45-degree field of view:
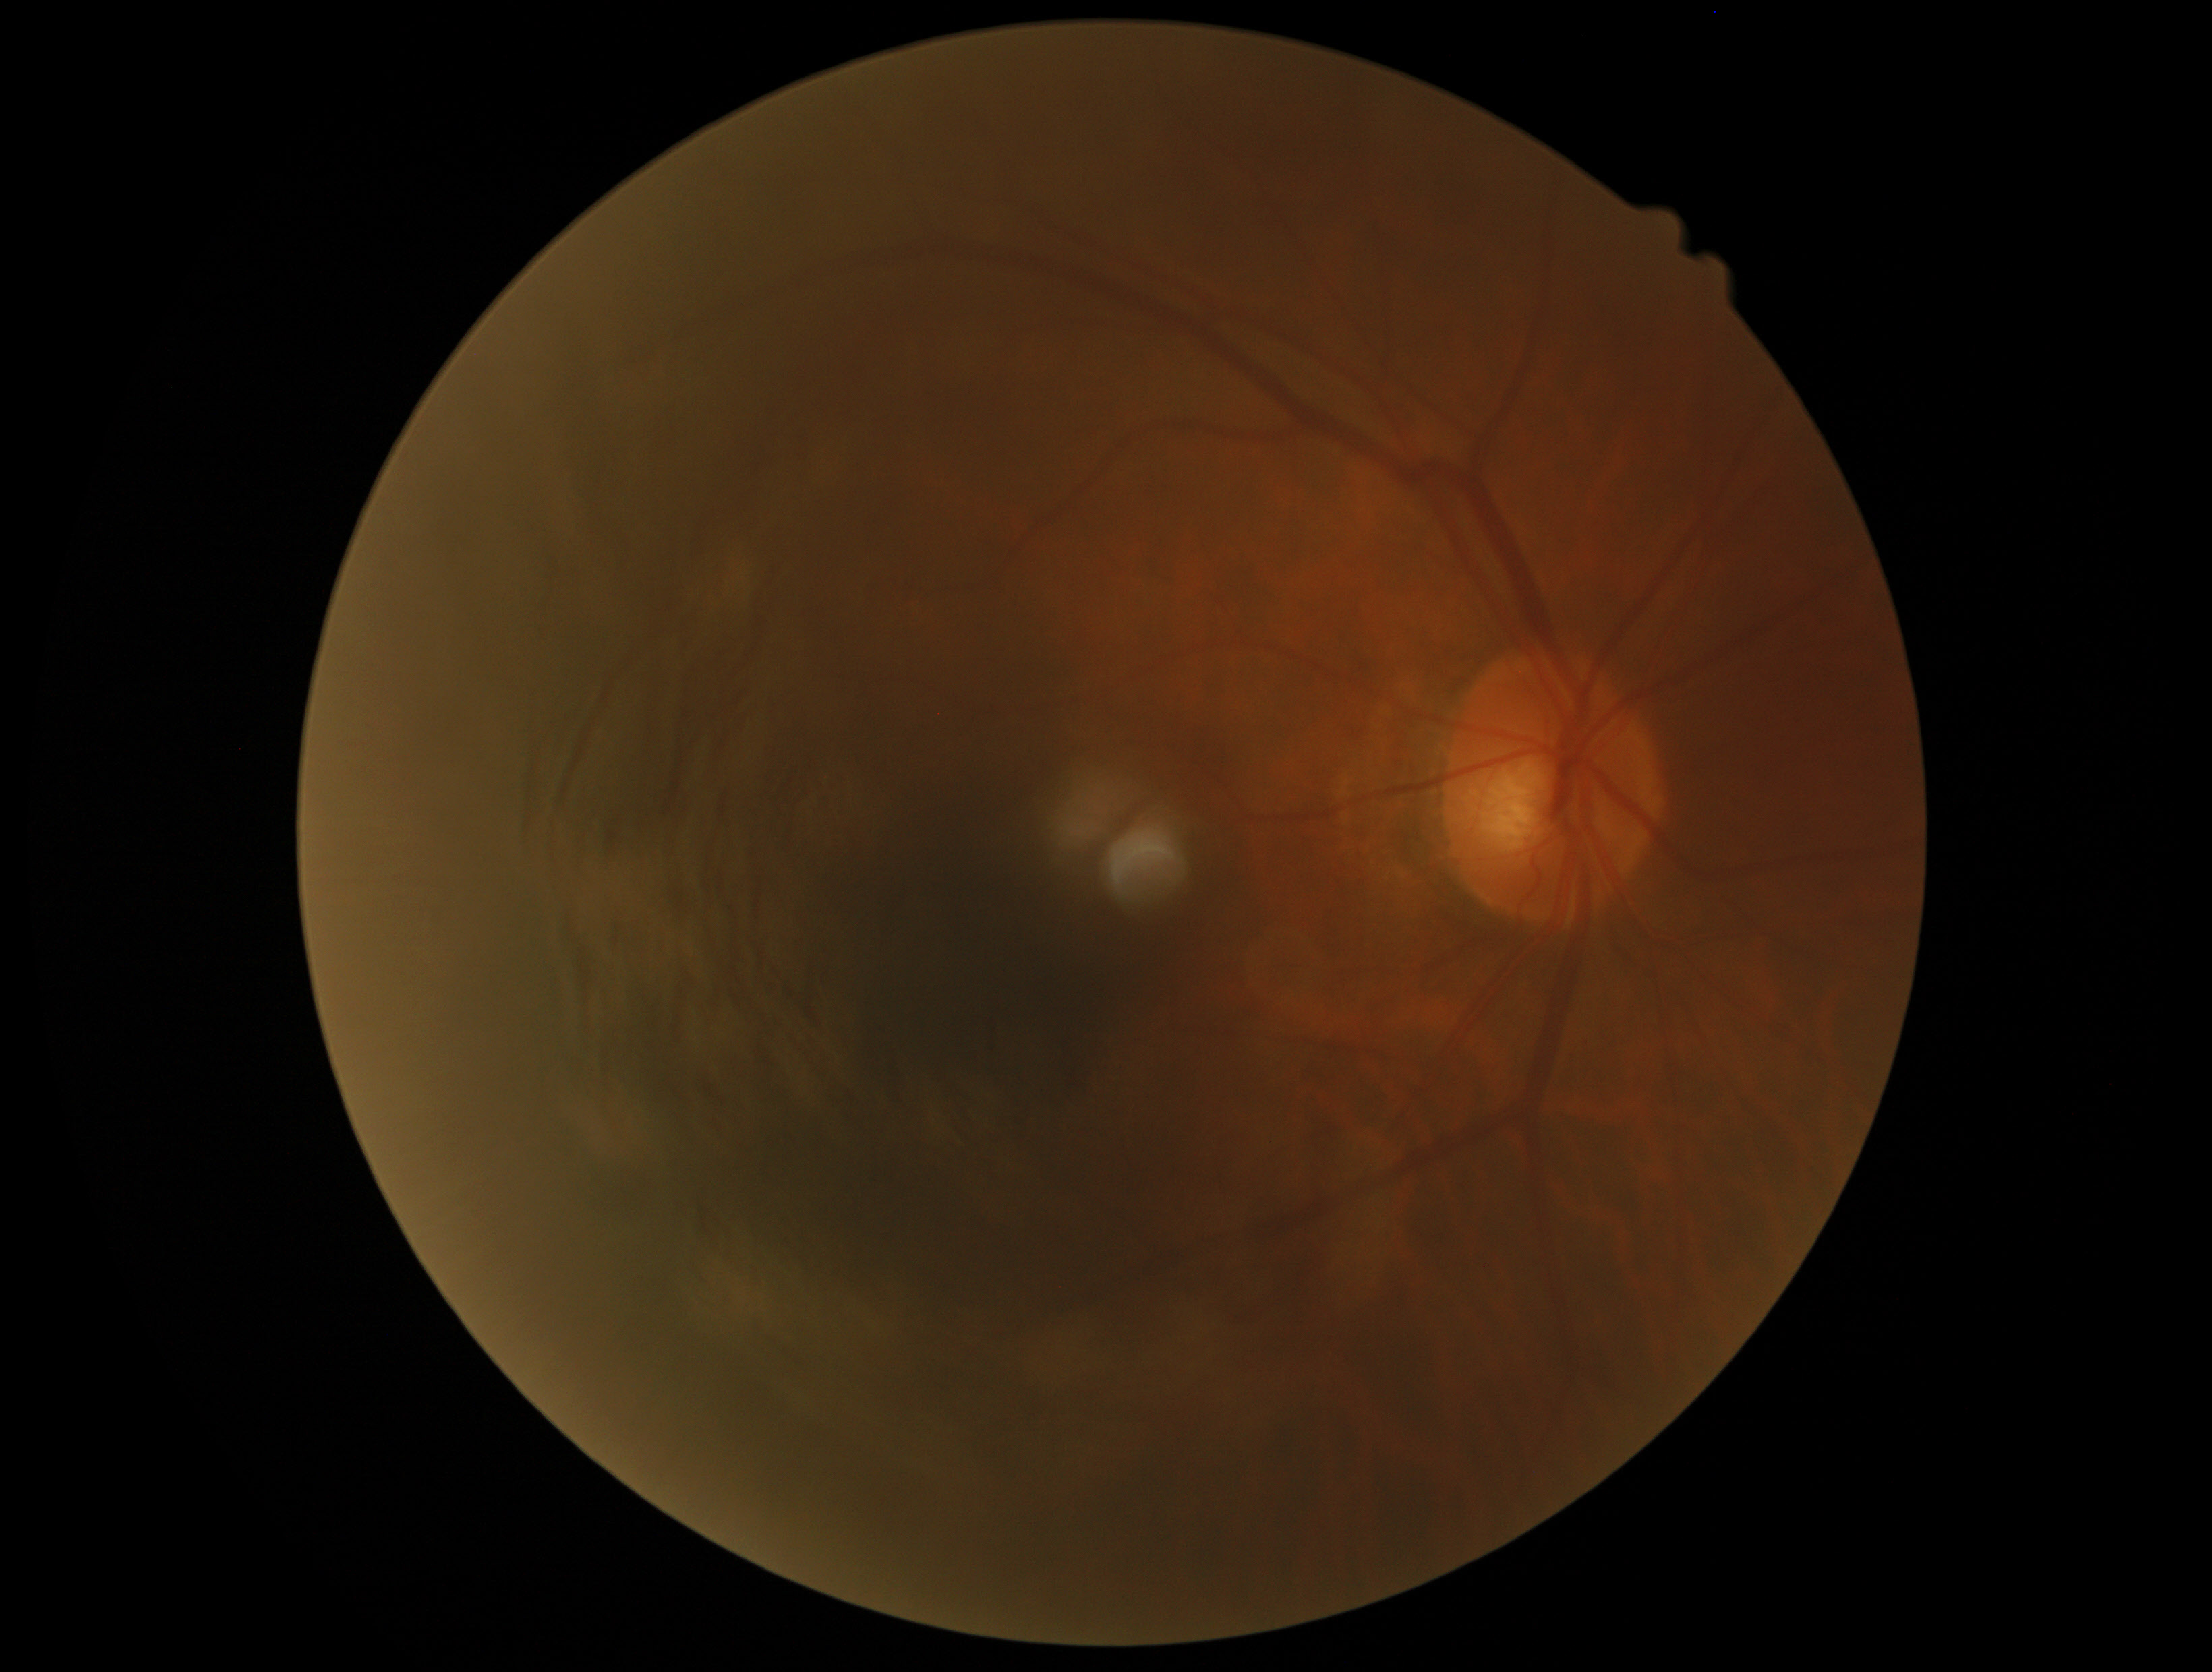
Diabetic retinopathy: no apparent retinopathy (grade 0).